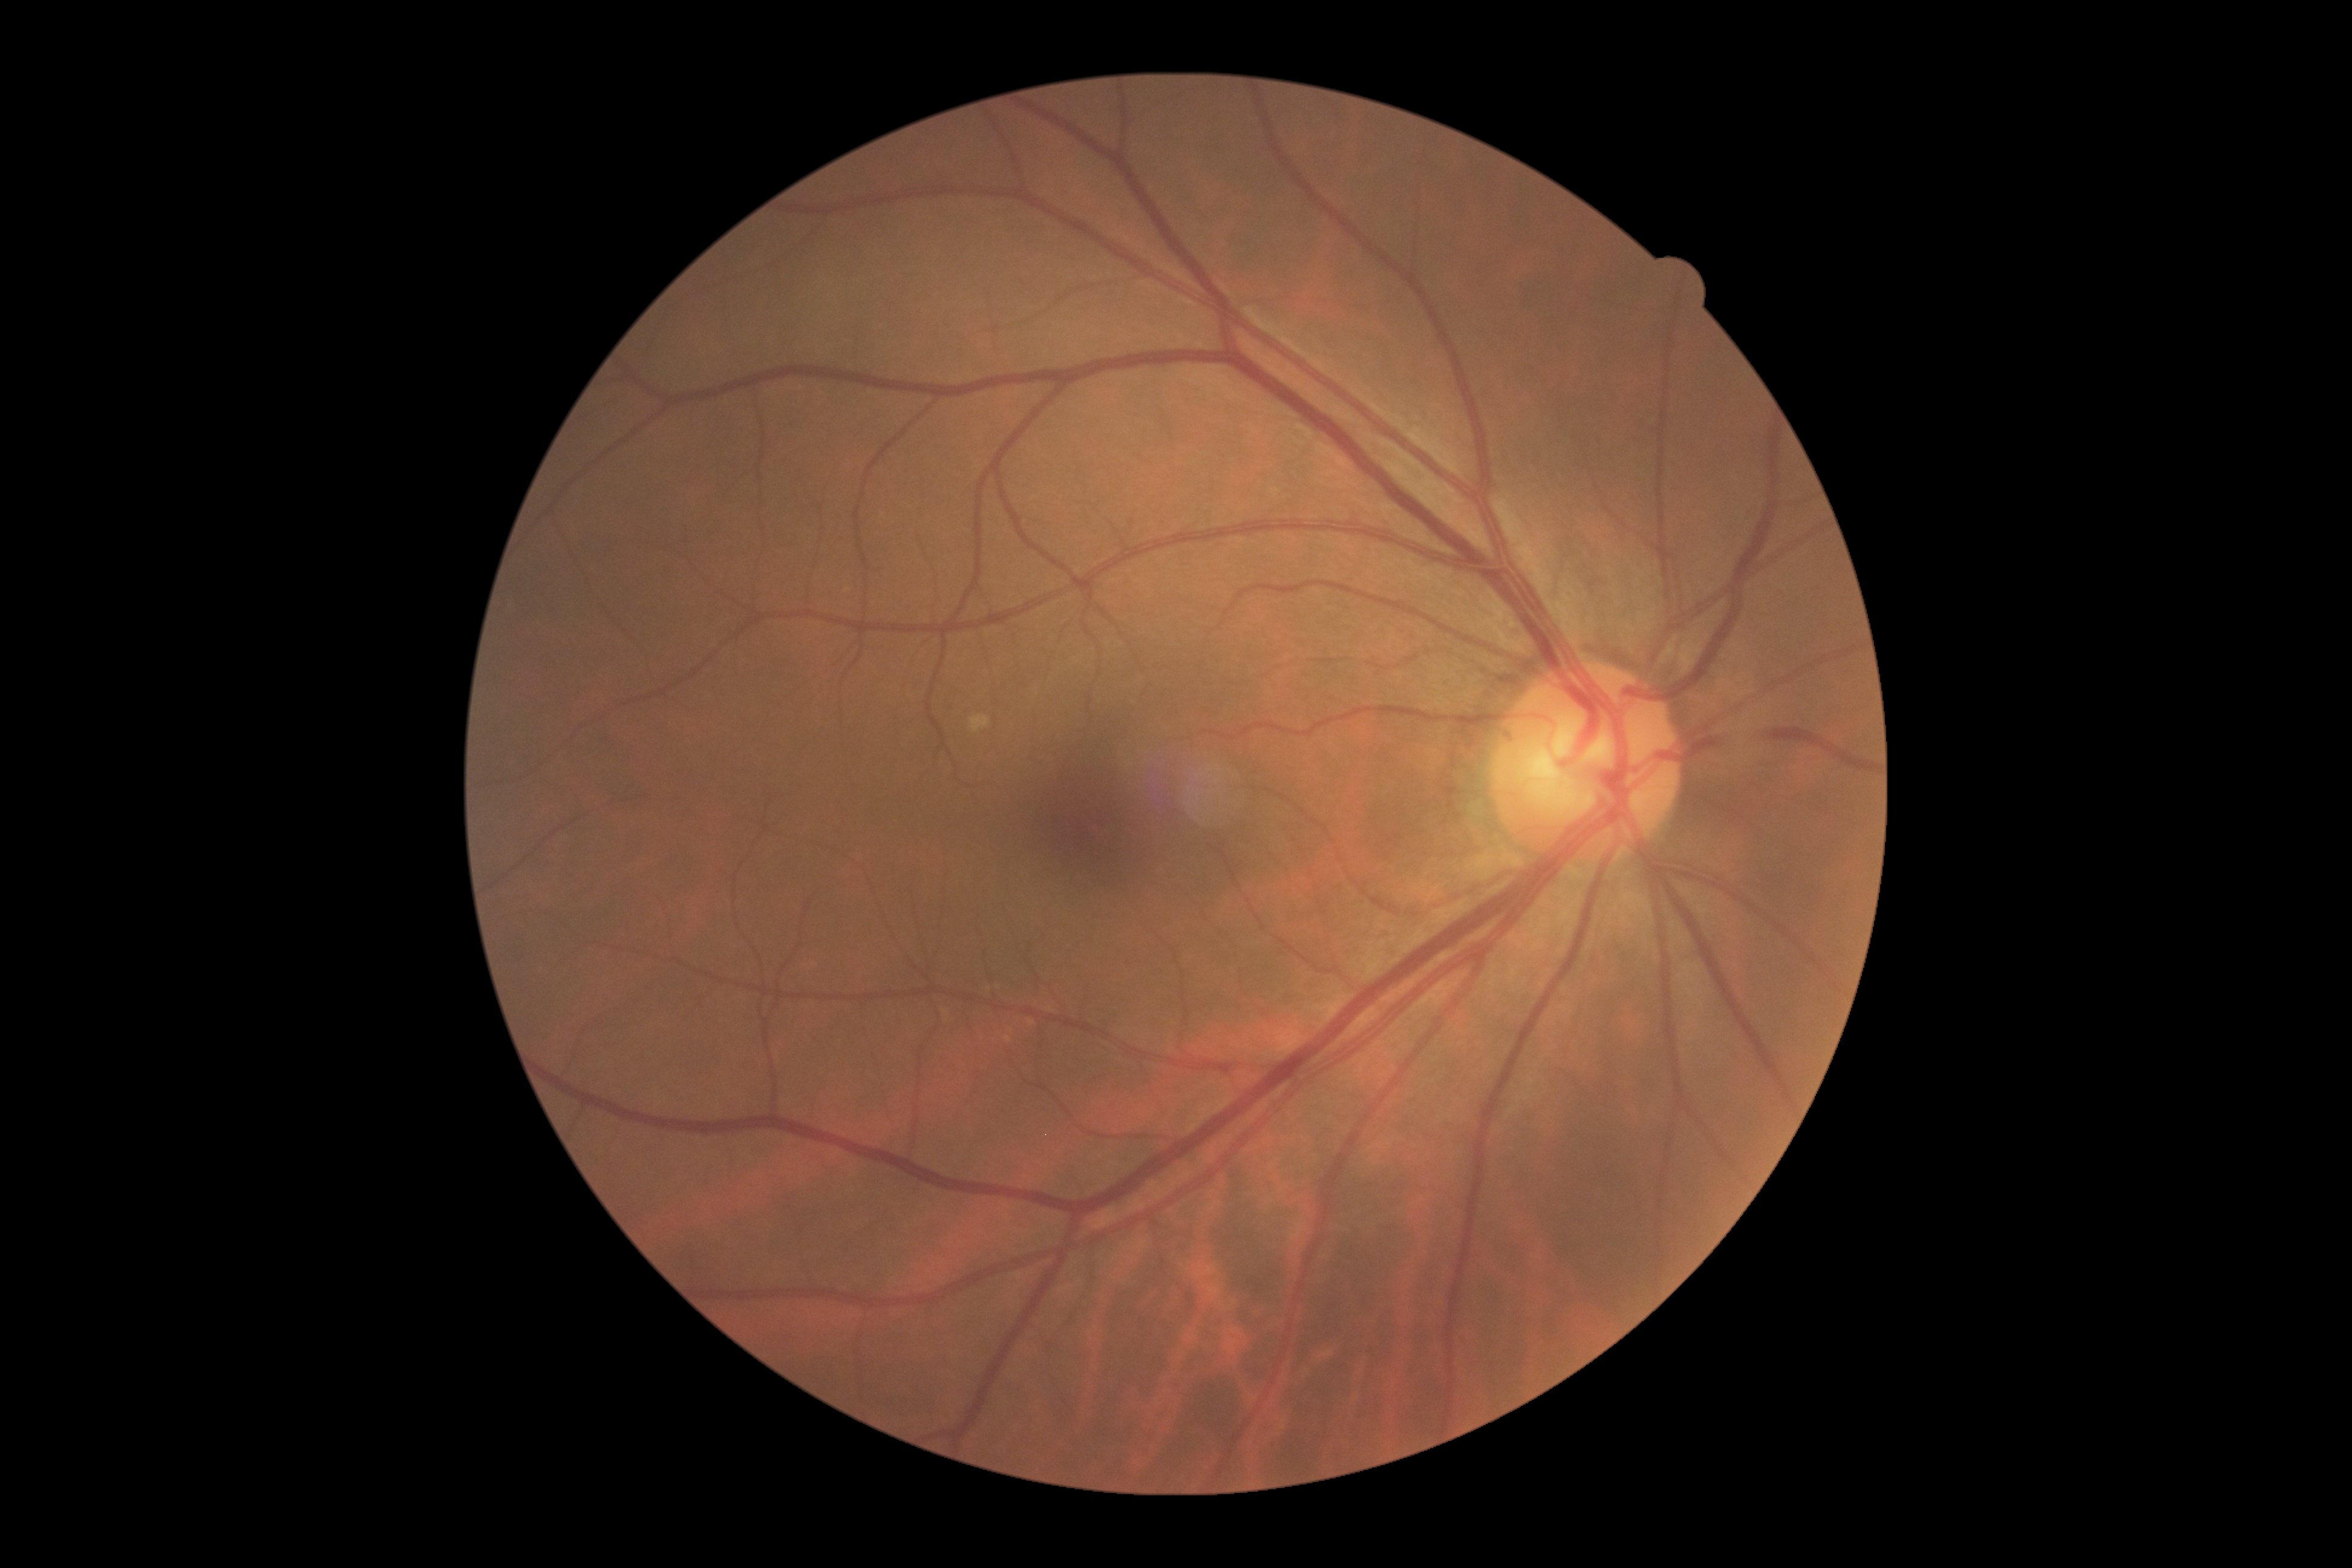

Annotations:
- diabetic retinopathy grade — no apparent diabetic retinopathy (0)
- DR impression — negative for DR